Color fundus image · image size 2361x1568 · Kowa VX-10α · macula-centered.
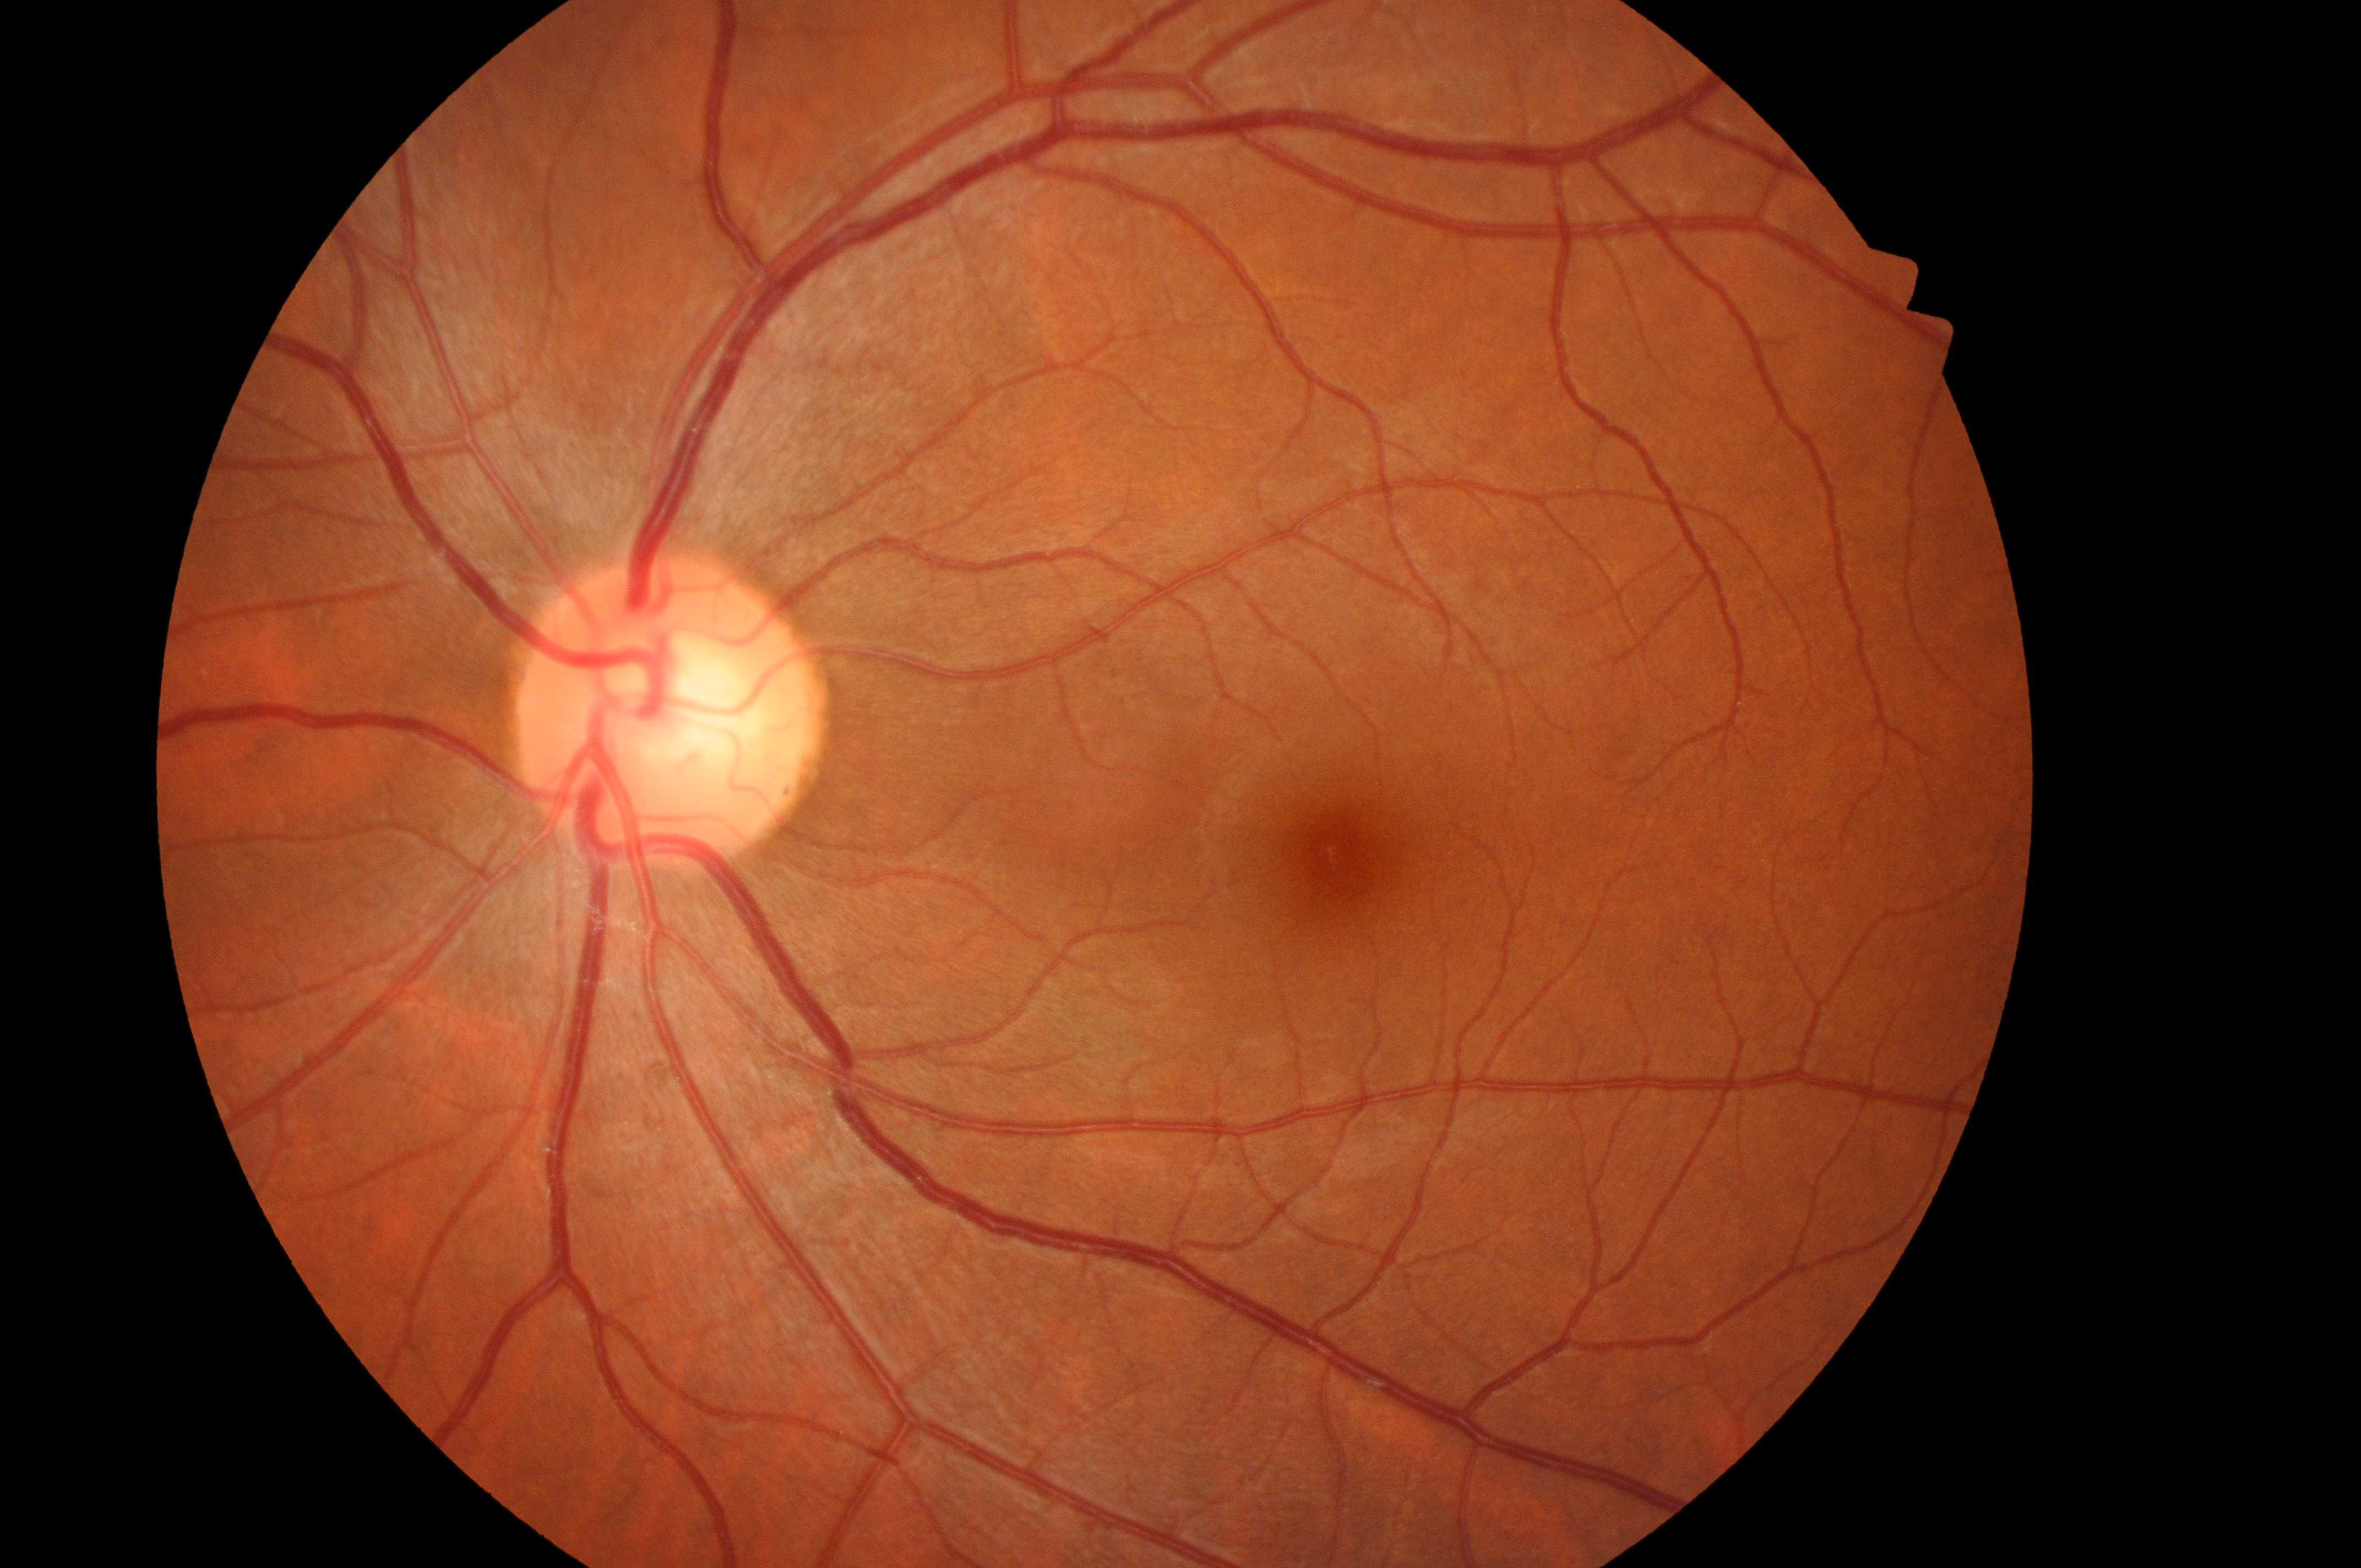
The macula center is at (1345,858). Diabetic retinopathy (DR): no apparent diabetic retinopathy (grade 0). Diabetic macular edema (DME) is grade 0 (no risk). Optic disc center: (662,727). Eye: oculus sinister.